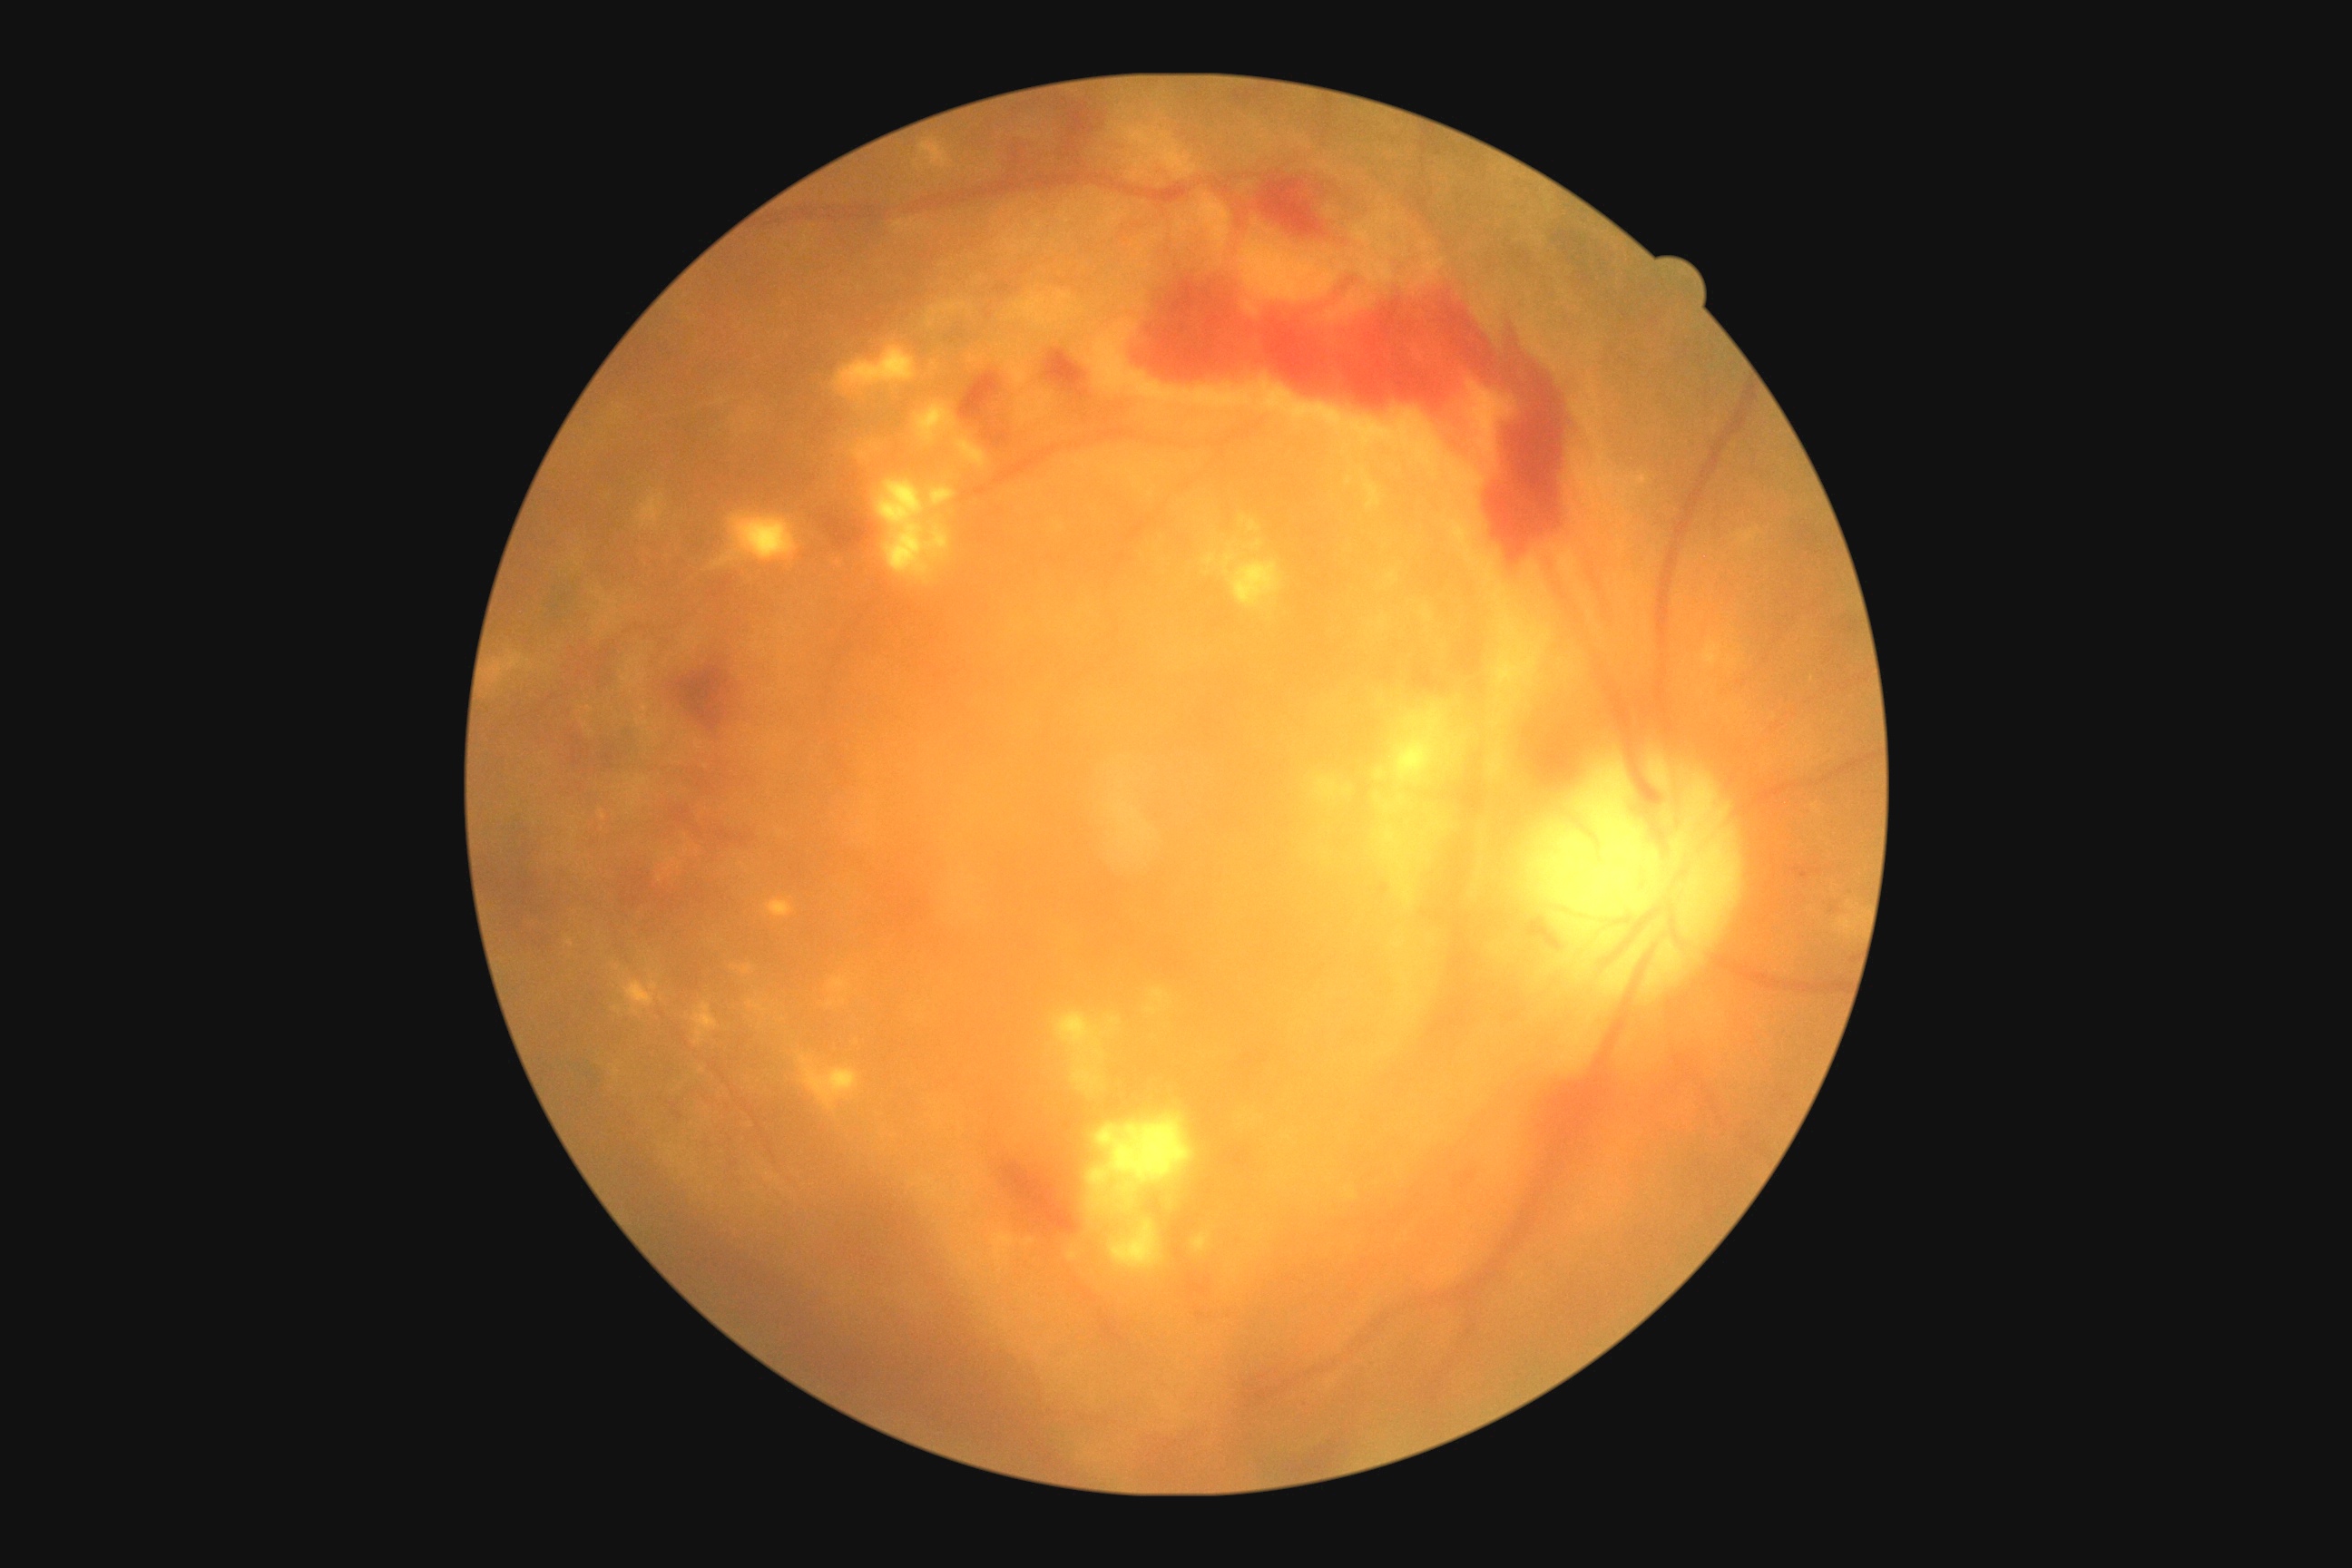
Diabetic retinopathy (DR) is proliferative diabetic retinopathy (grade 4) — neovascularization and/or vitreous/pre-retinal hemorrhage.